848 by 848 pixels; diabetic retinopathy graded by the modified Davis classification; 45 degree fundus photograph
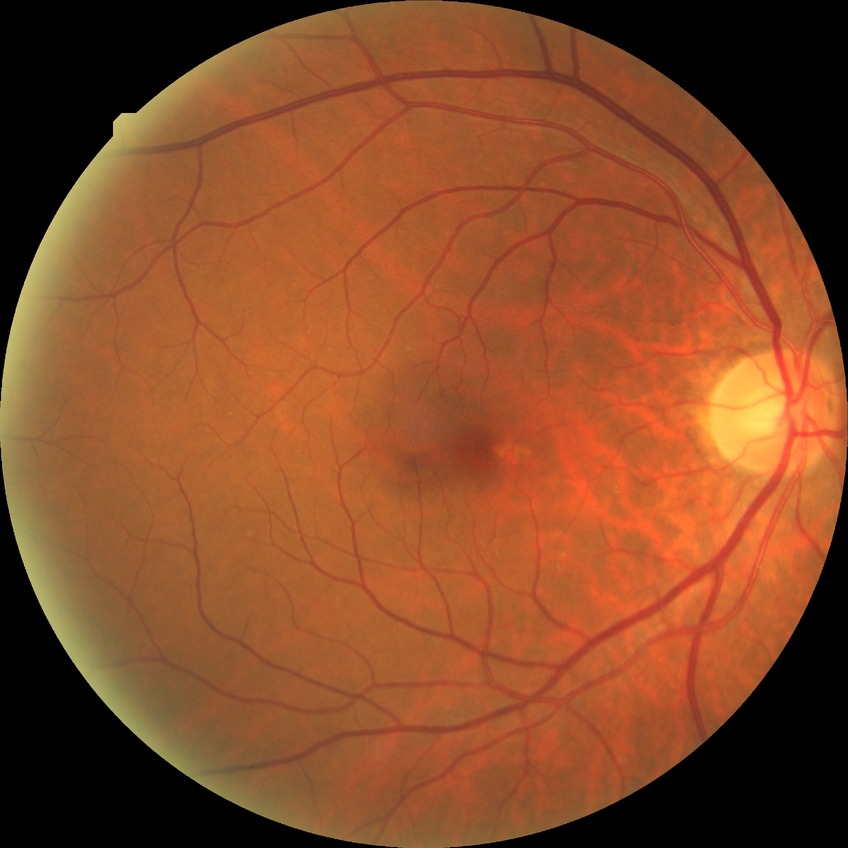

diabetic retinopathy (DR)=SDR (simple diabetic retinopathy).